FOV: 45 degrees
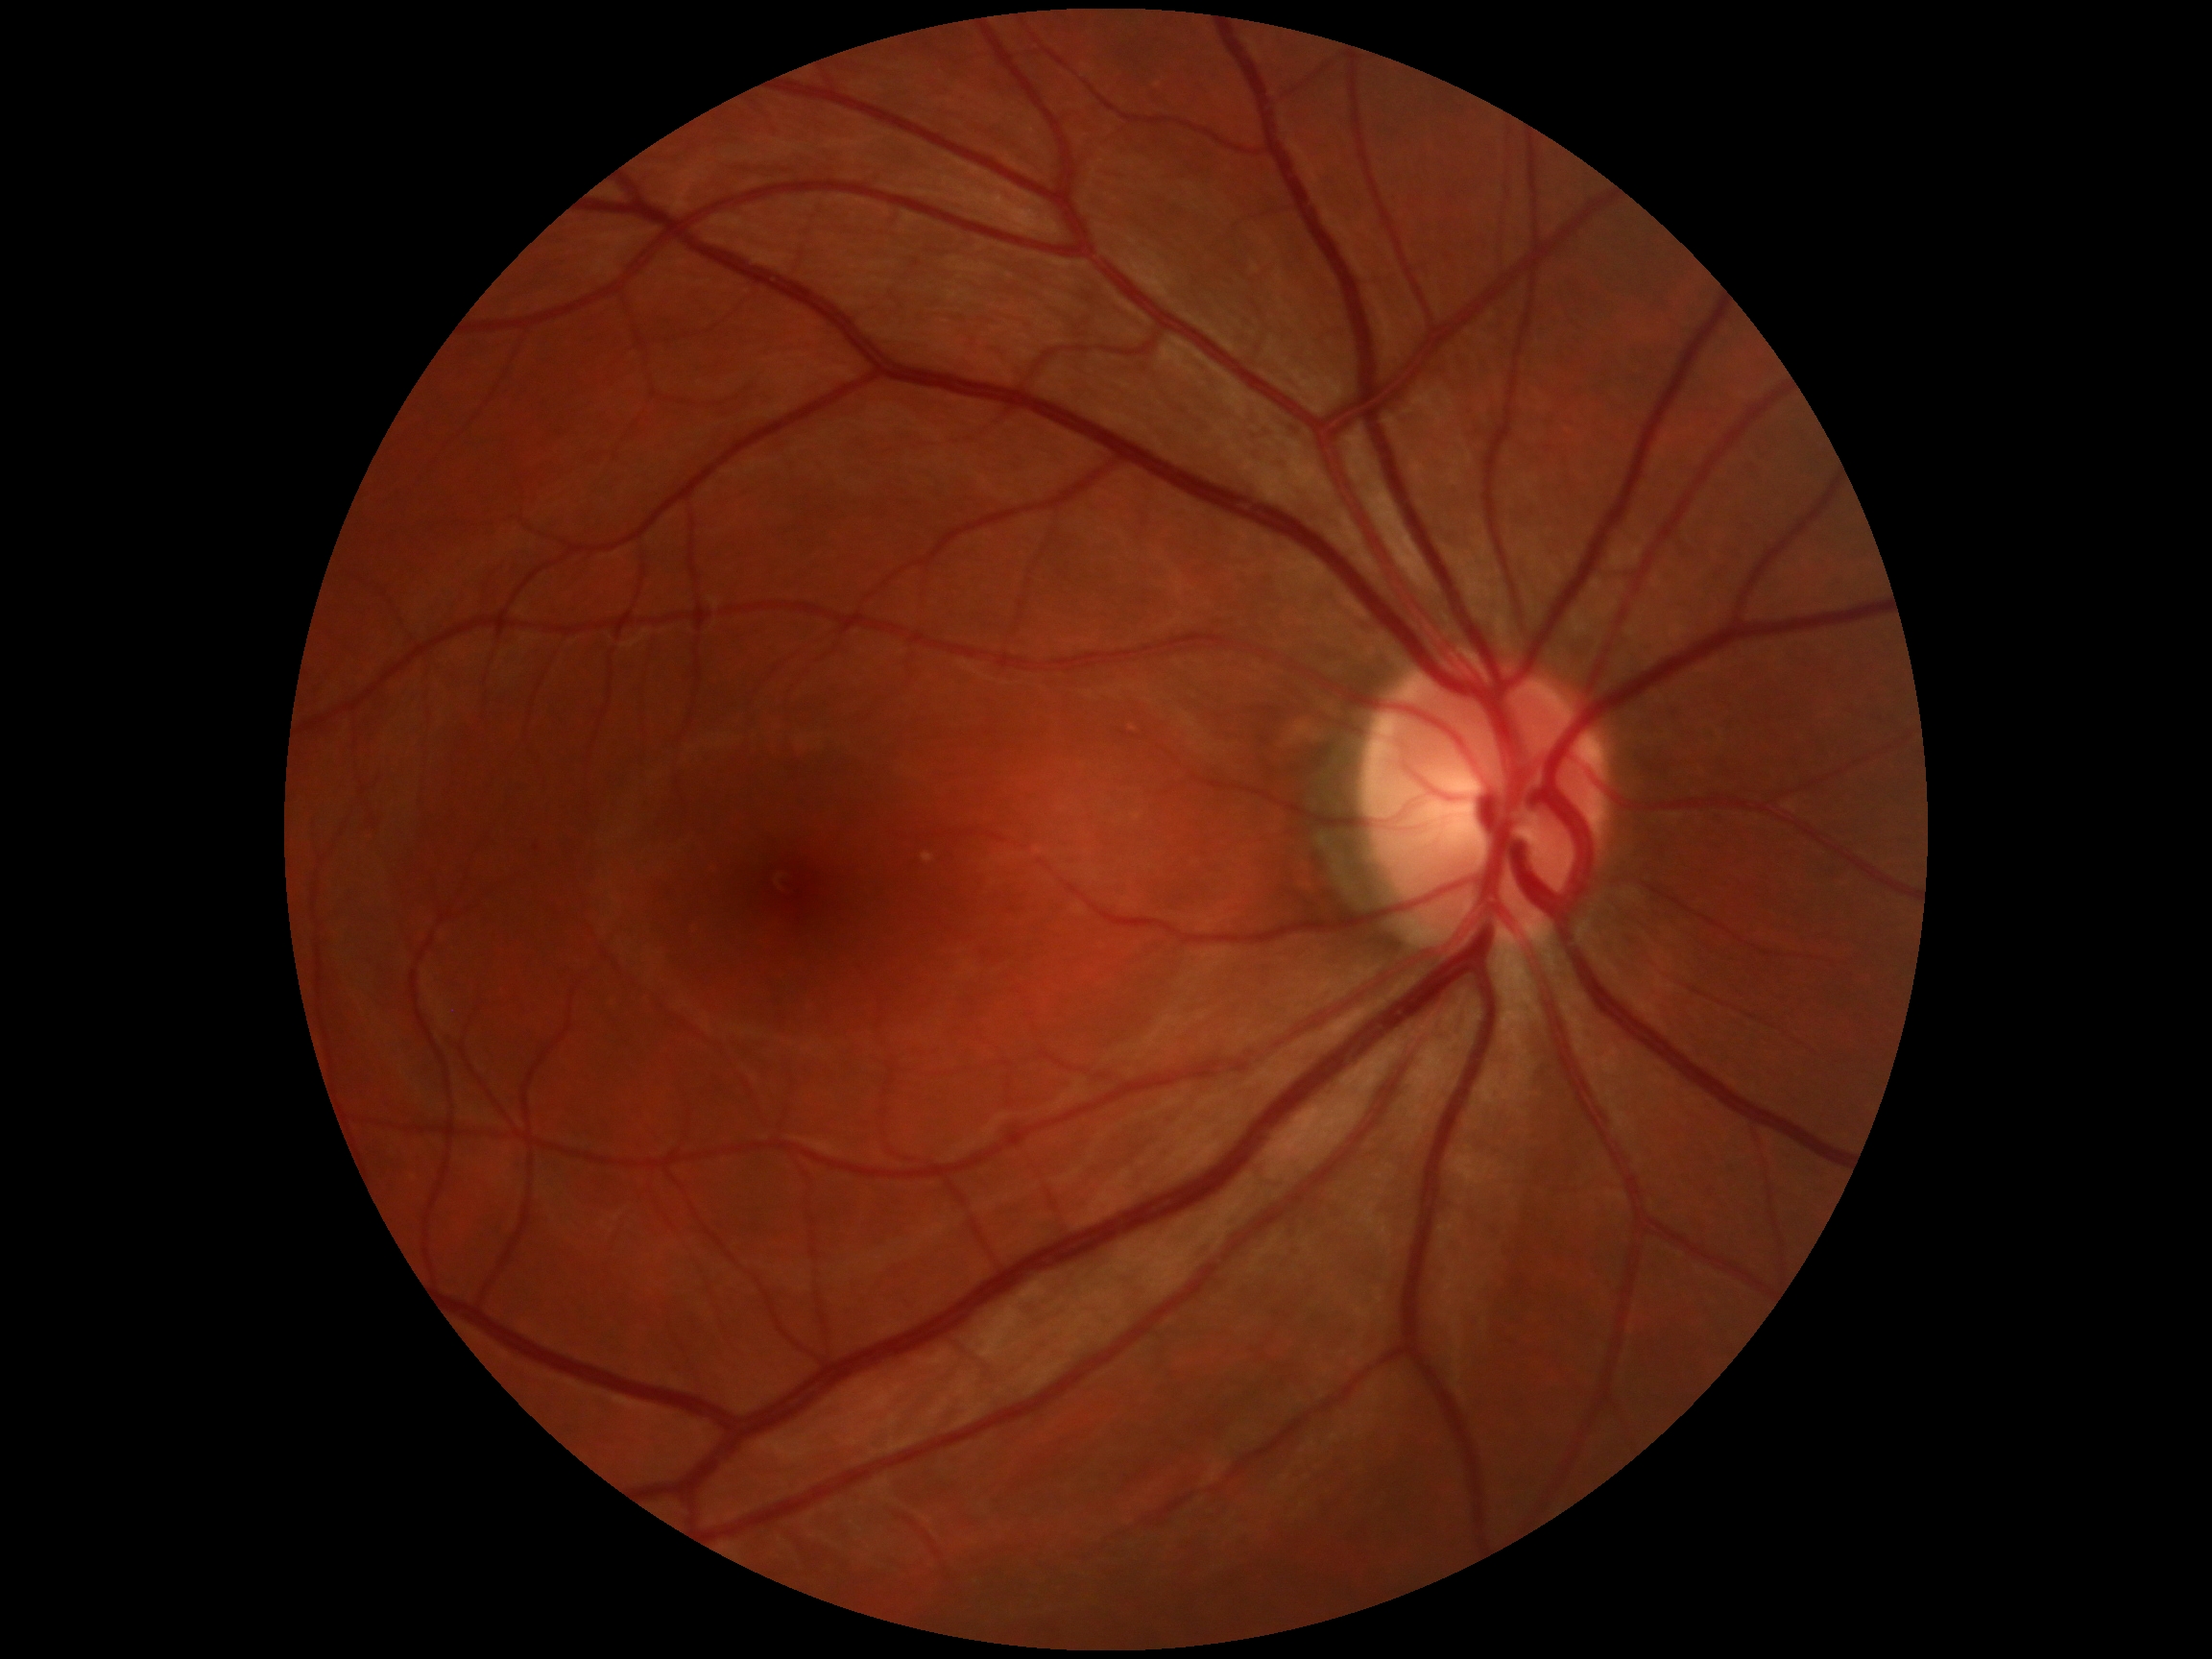 Diabetic retinopathy grade: 0 (no apparent retinopathy).